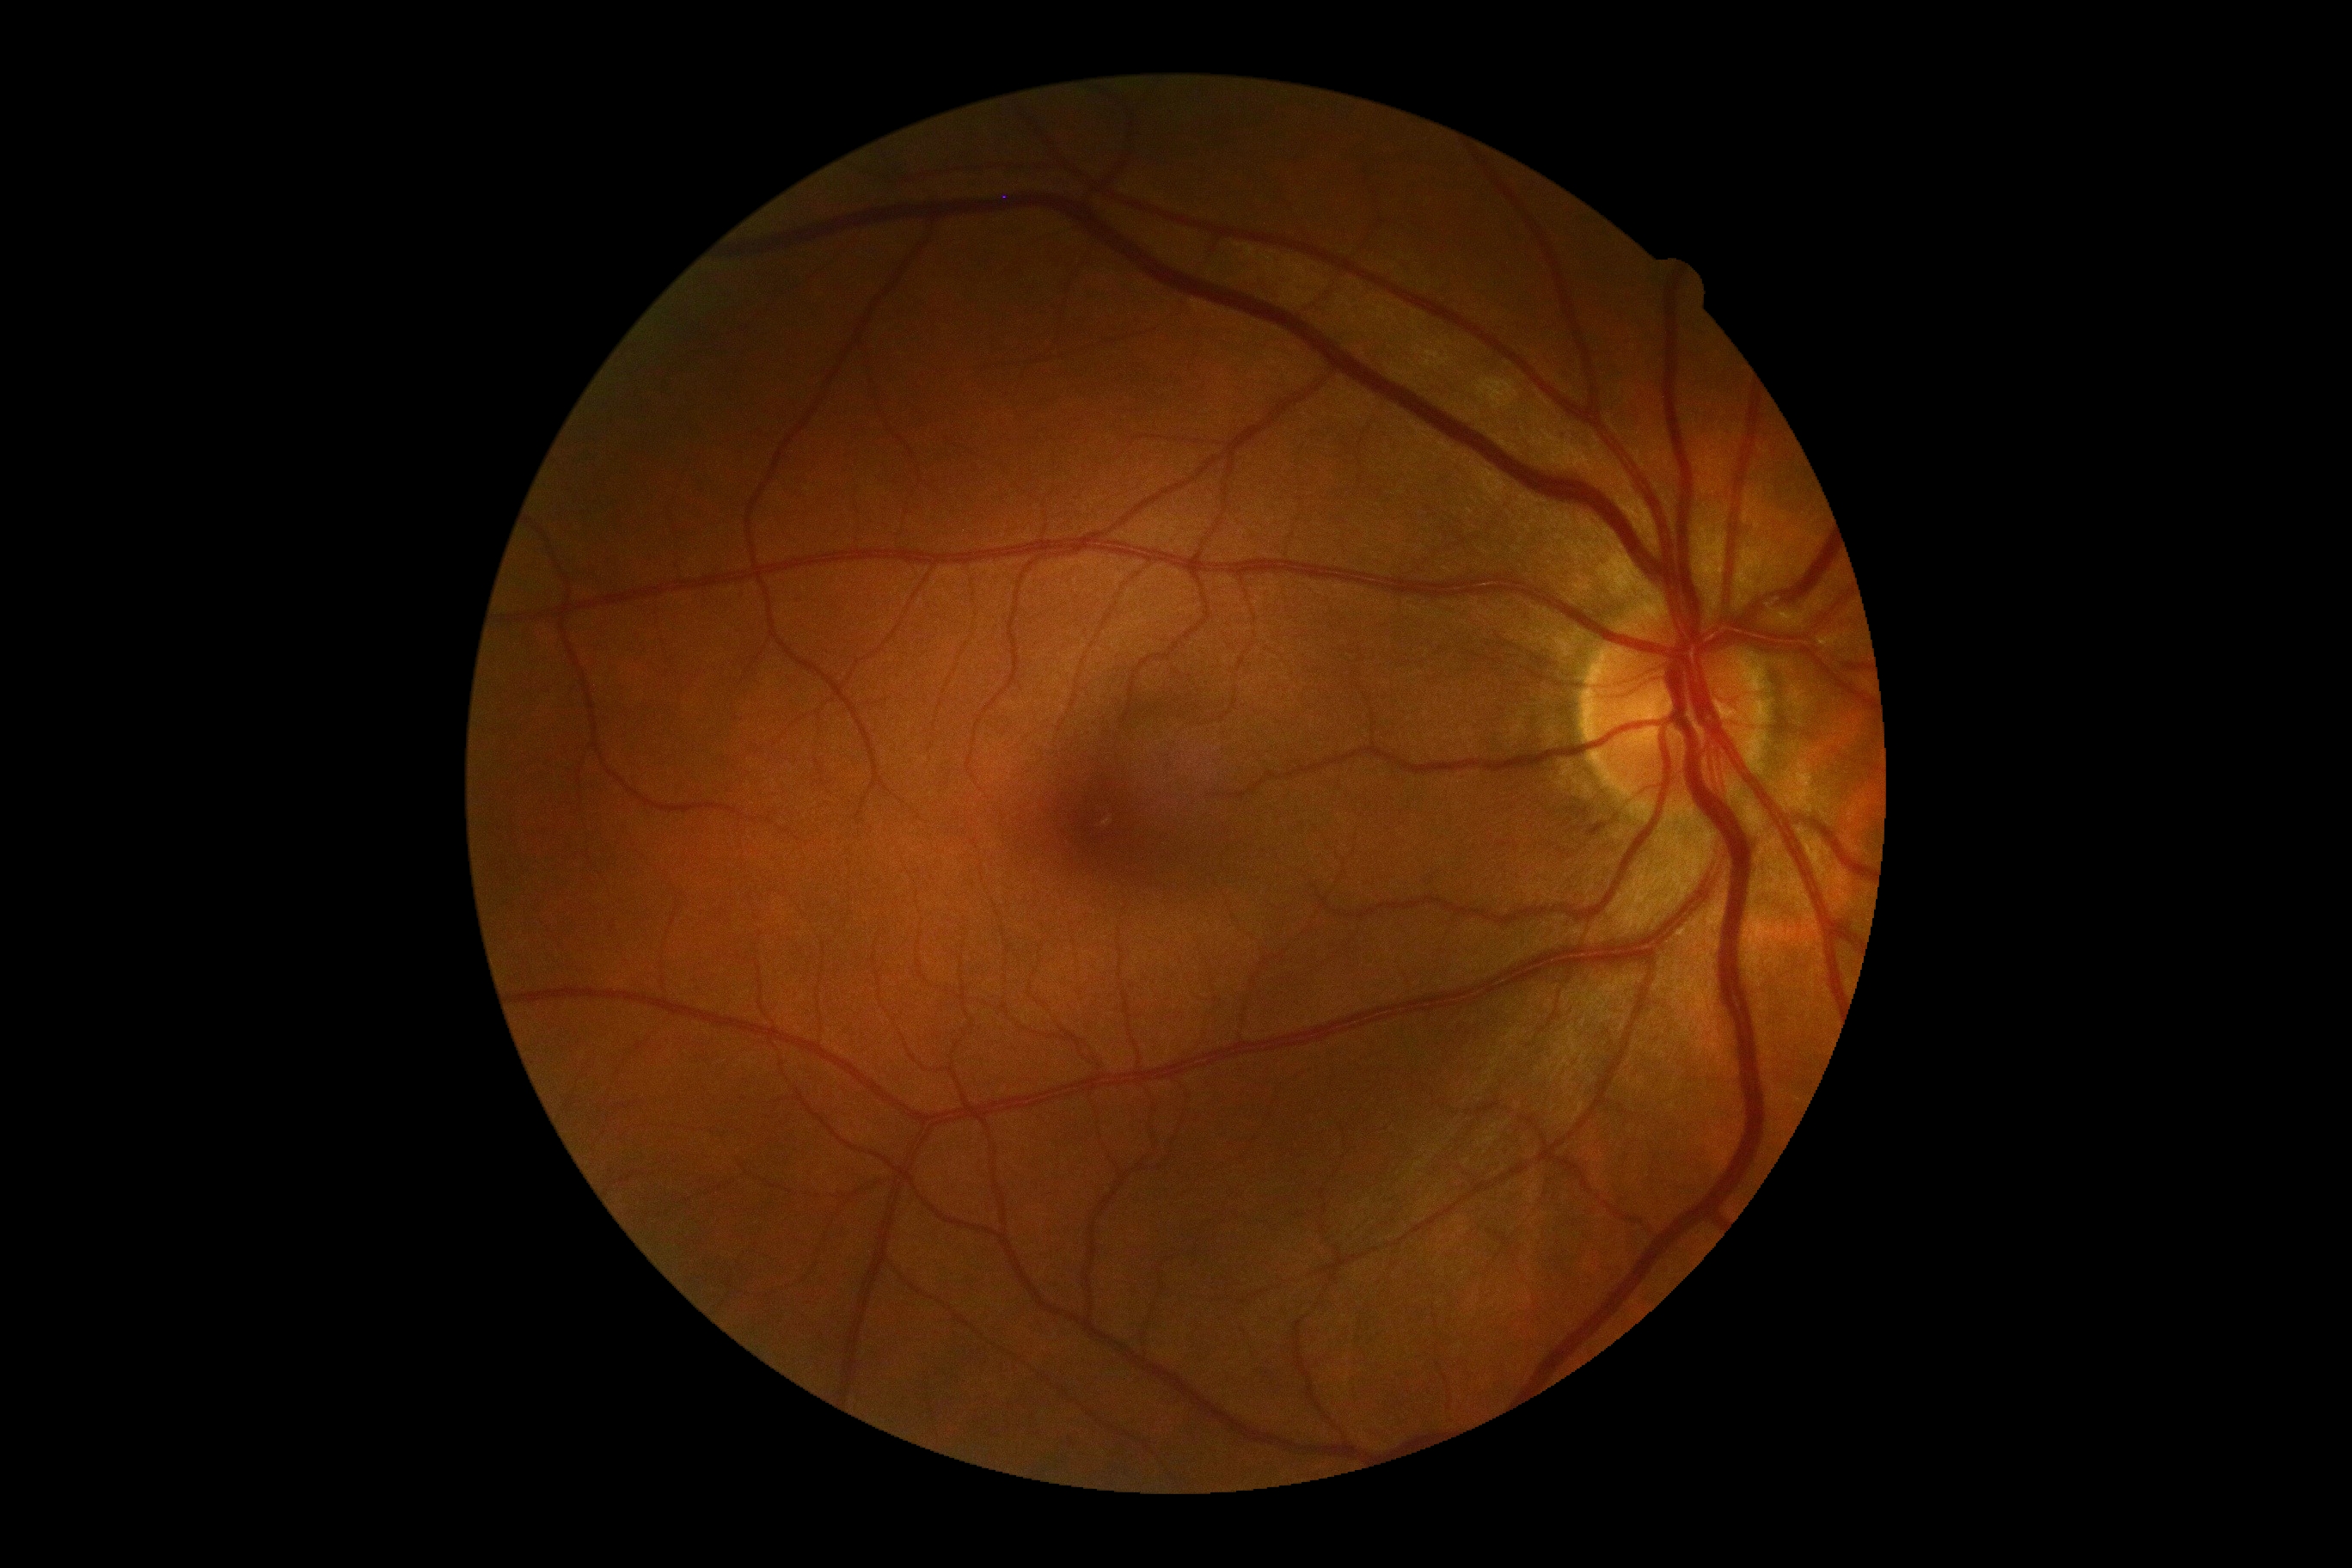 DR impression@negative for DR, diabetic retinopathy@0/4.